2048x1536
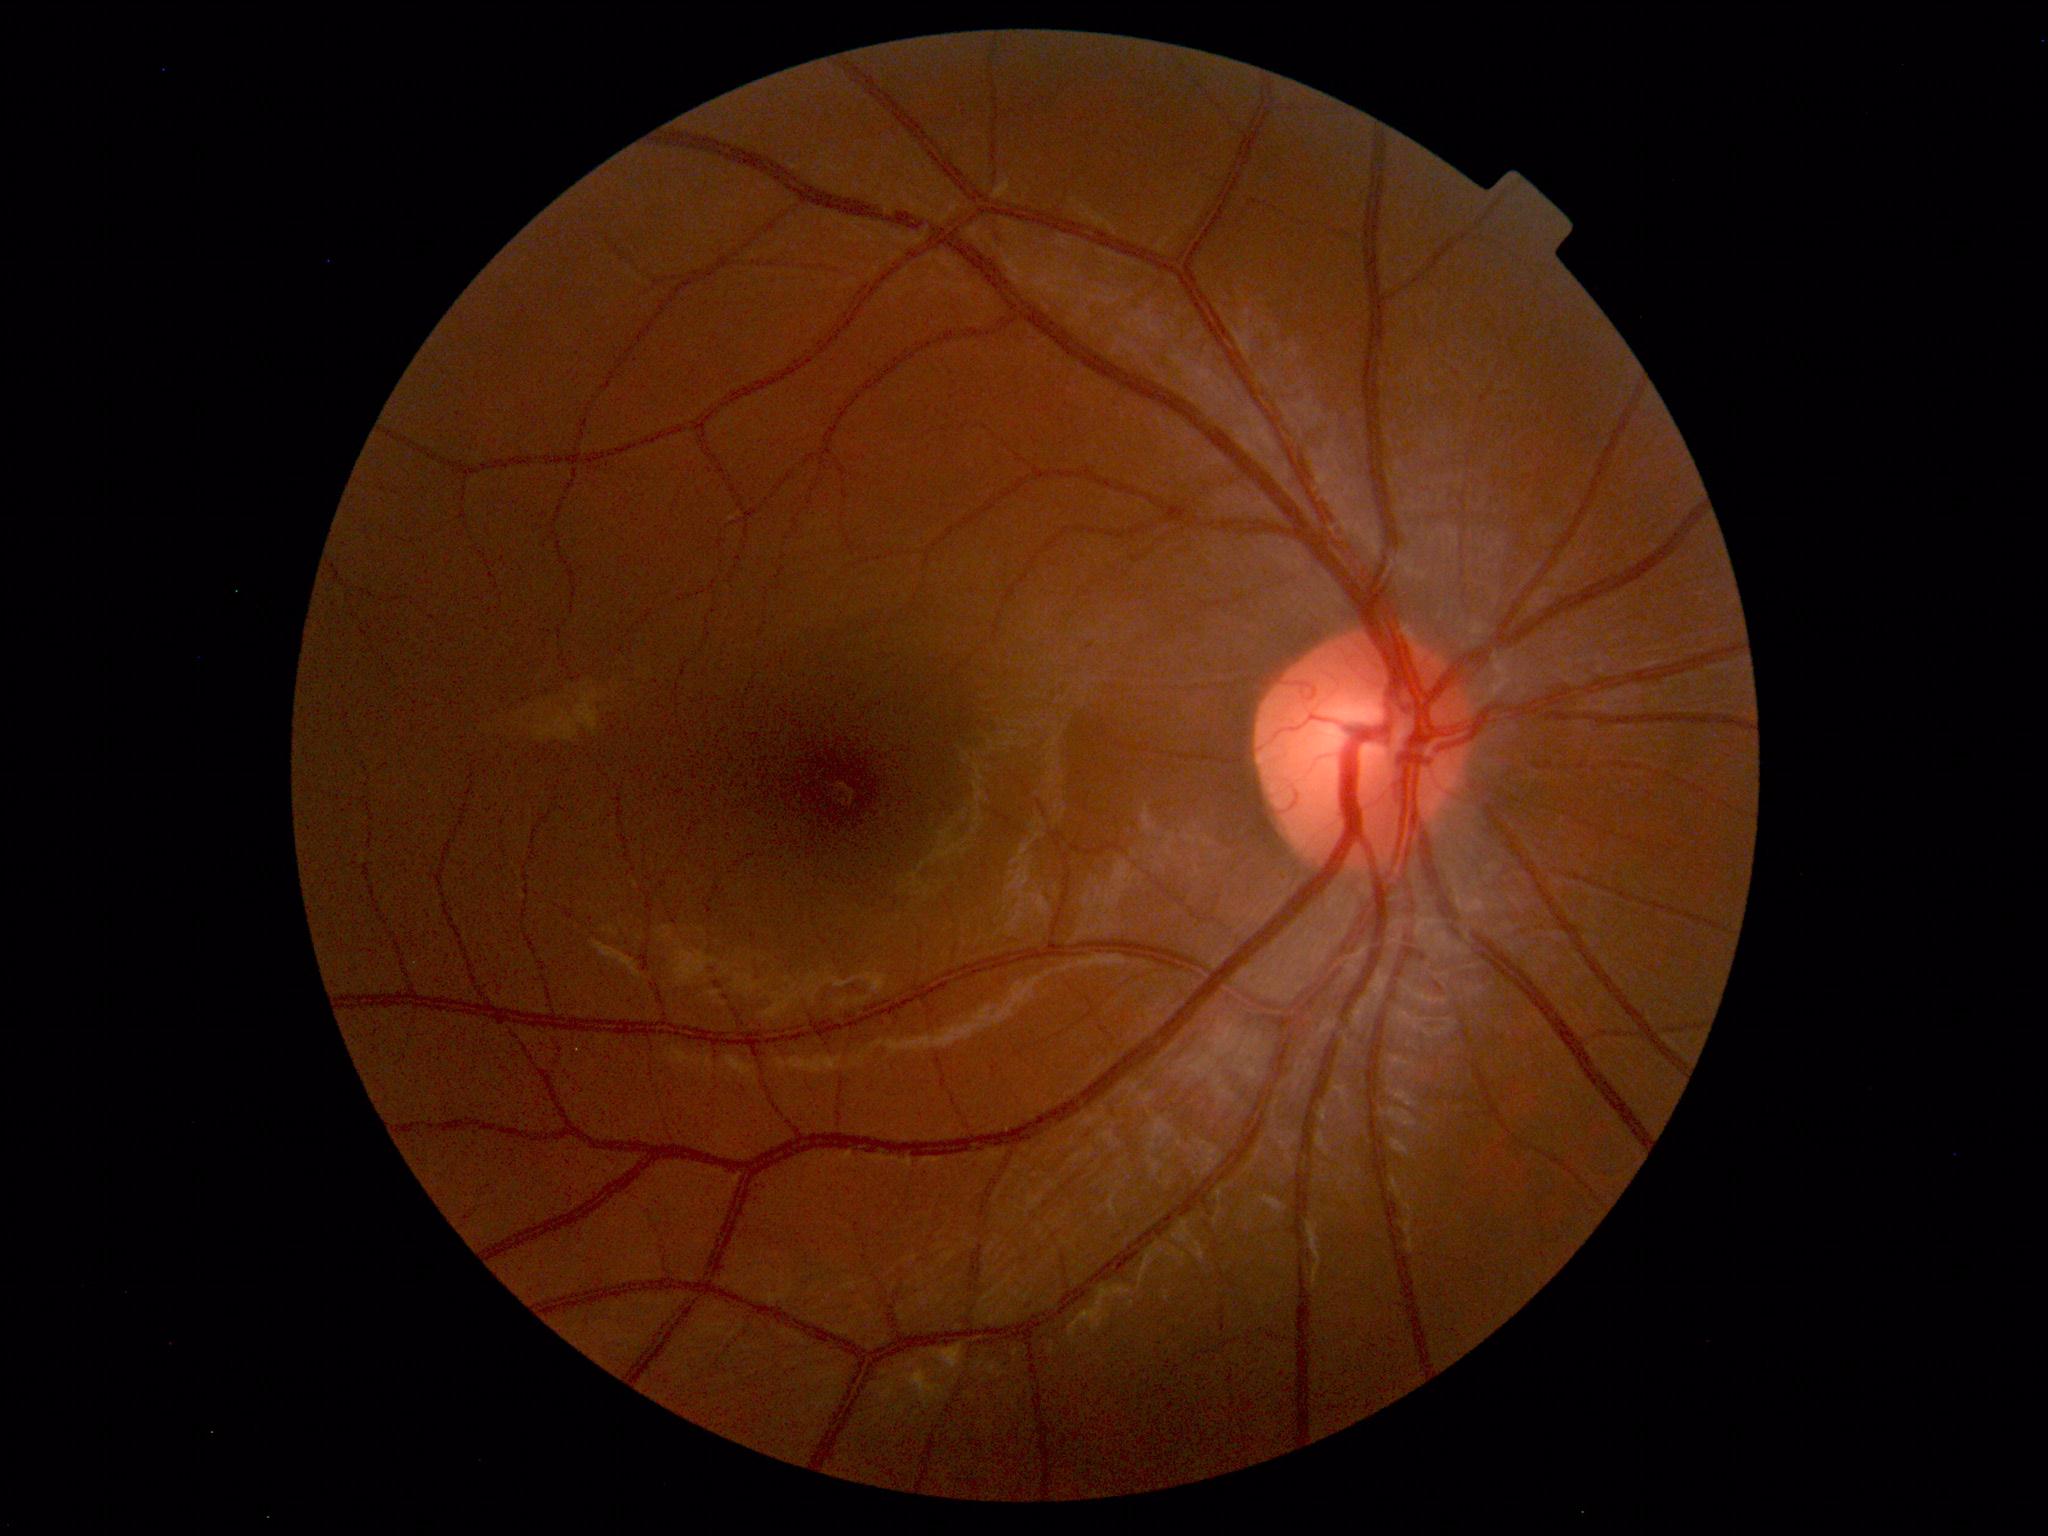 Diagnosis: normal.